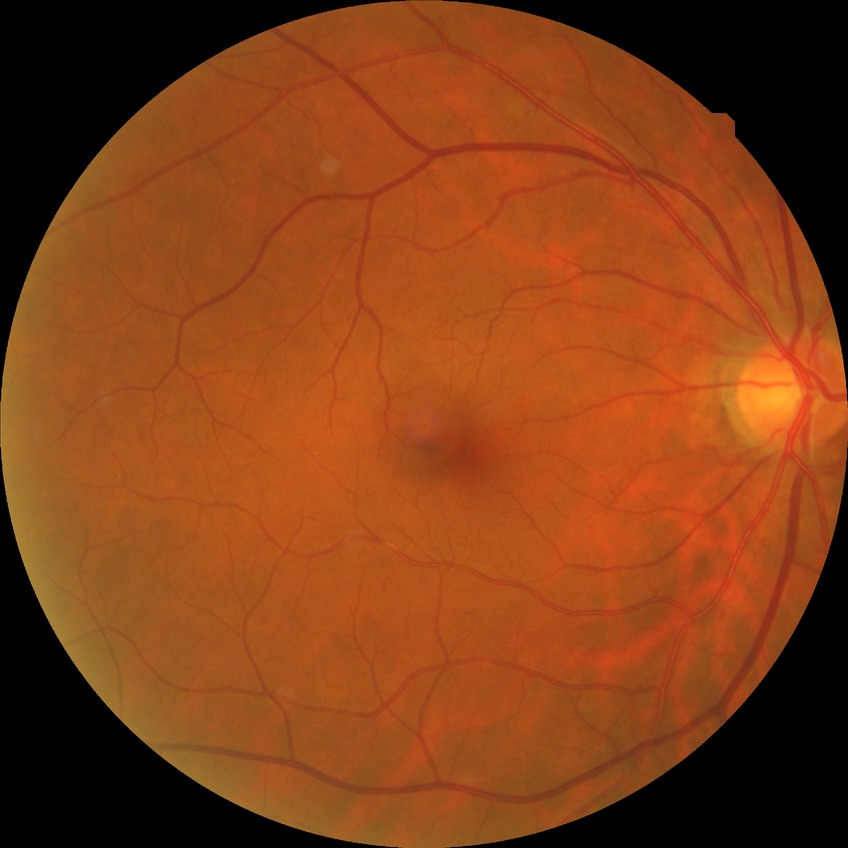 DR impression@no signs of DR, DR stage@NDR.